RetCam wide-field infant fundus image: 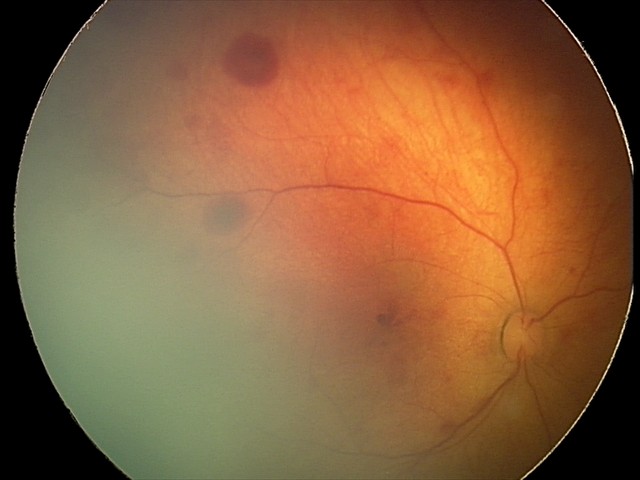
Assessment: retinal hemorrhages.